2352x1568
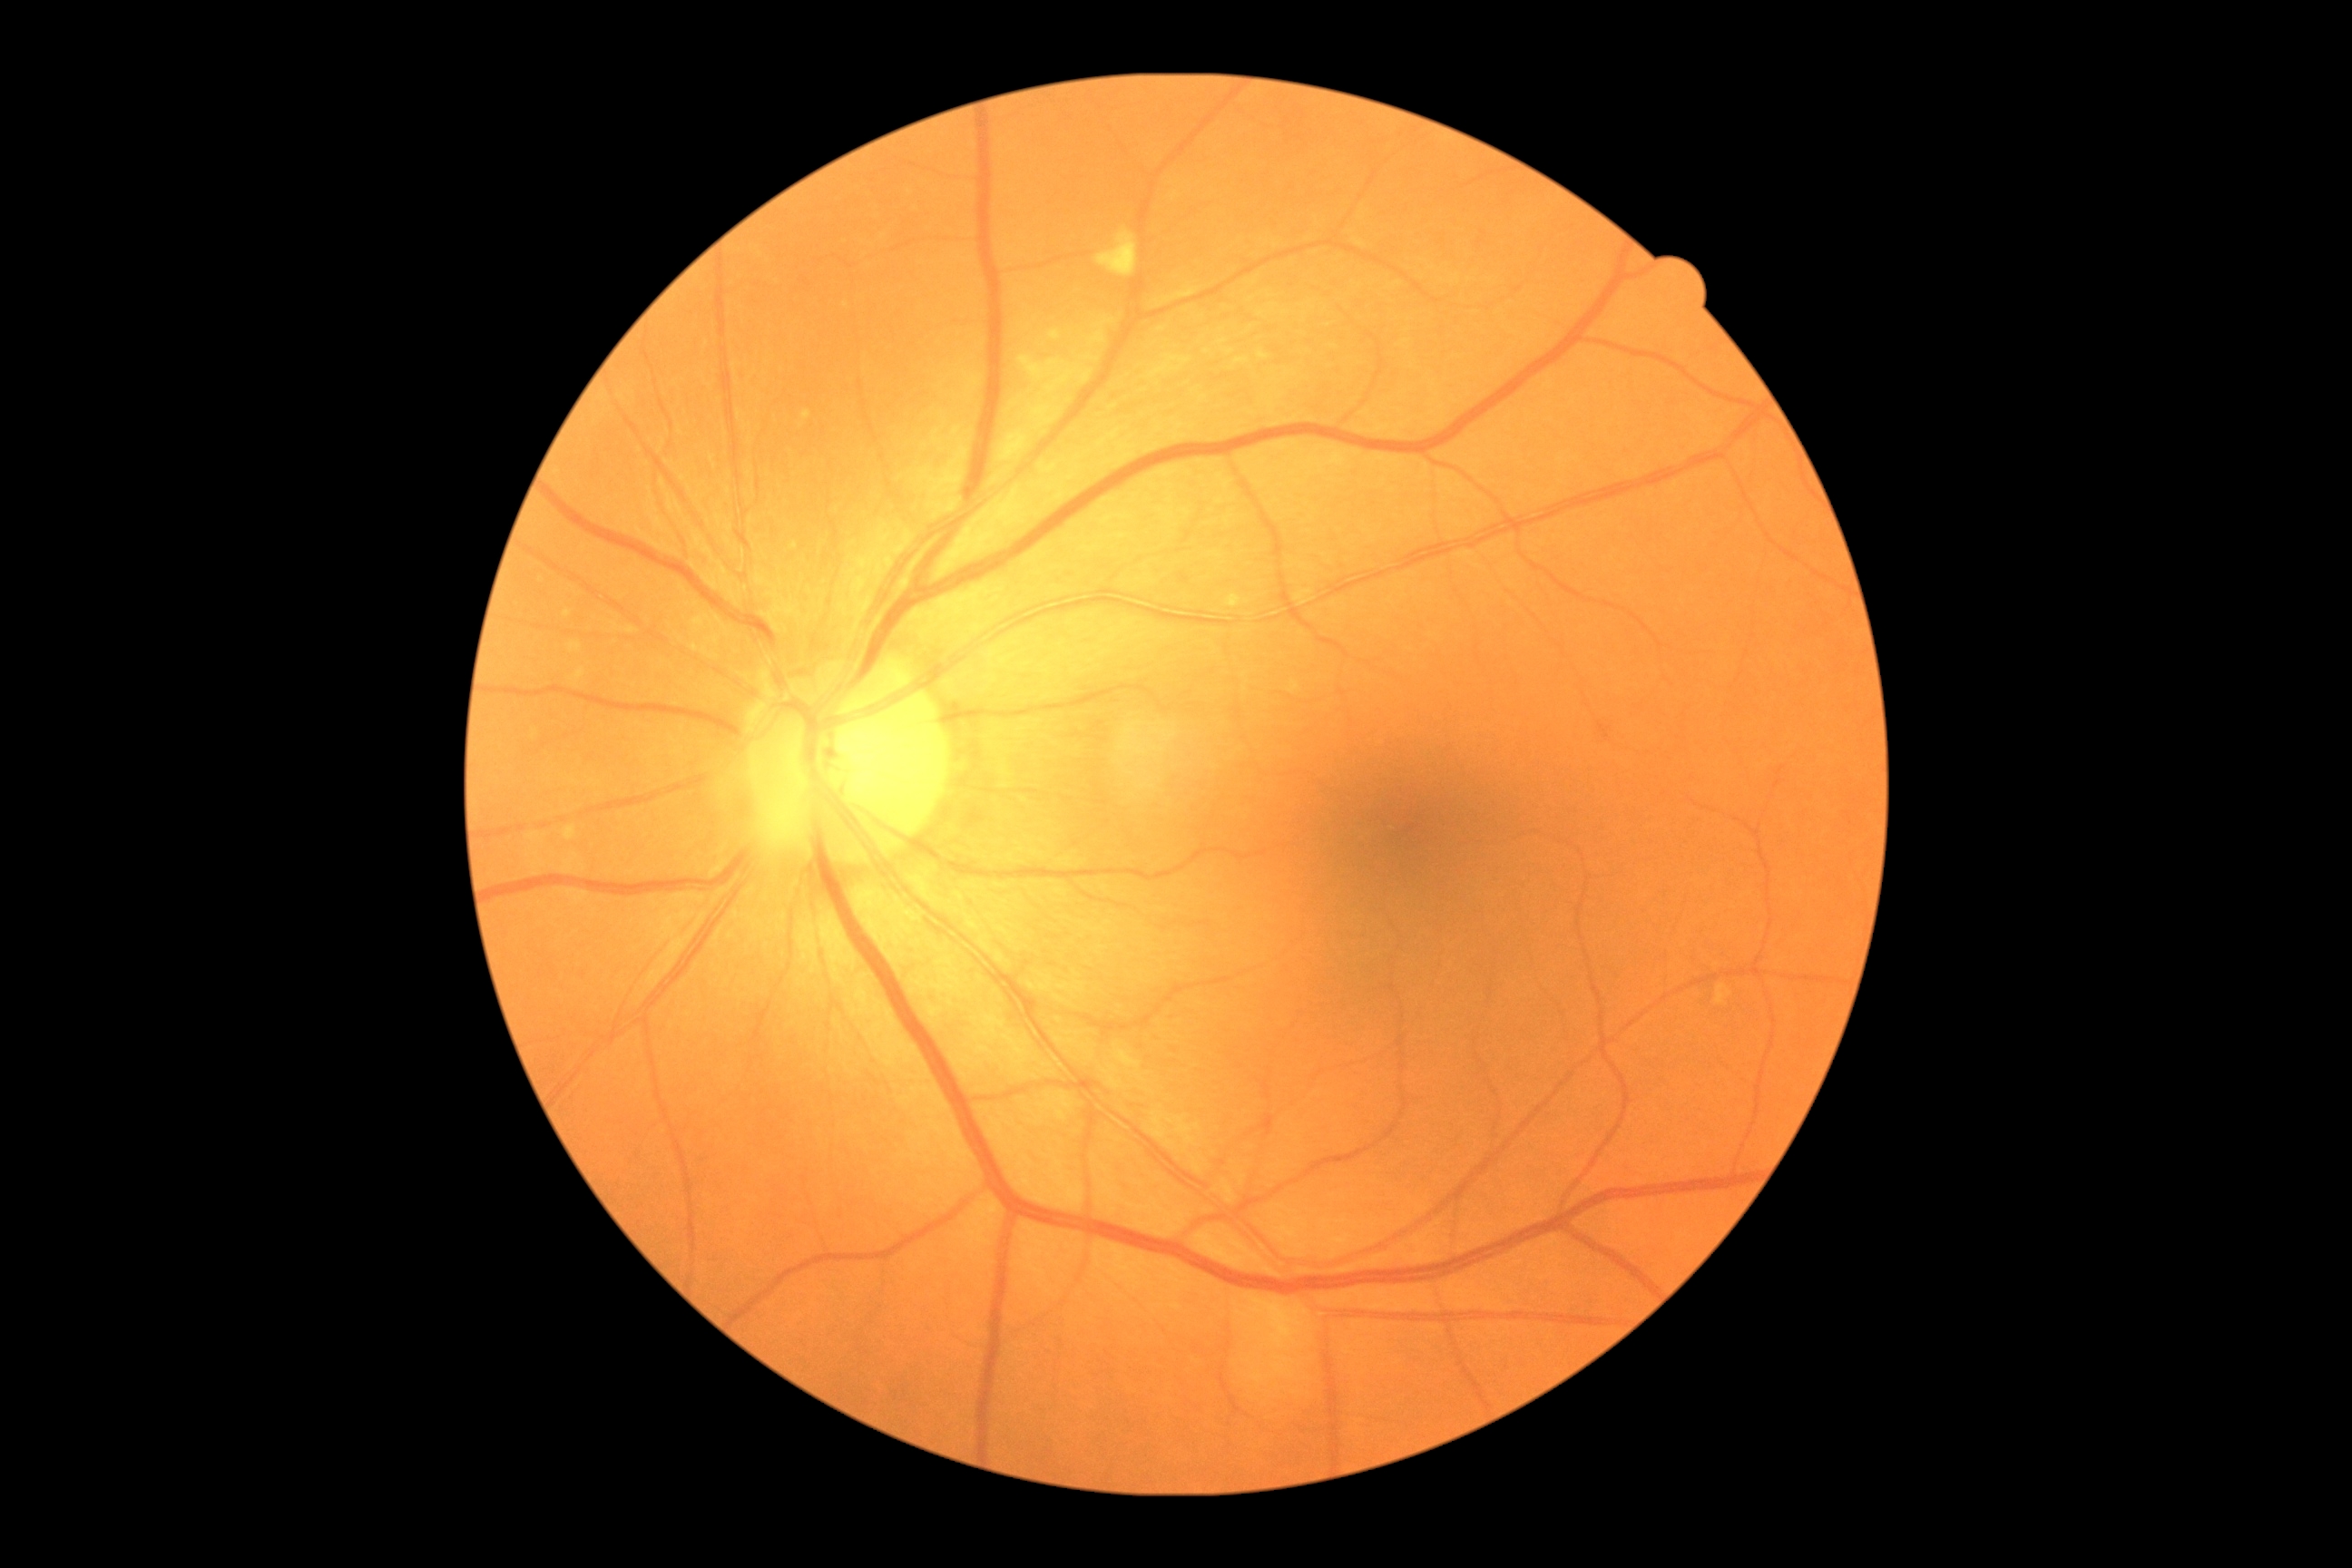 No signs of diabetic retinopathy.
Retinopathy: grade 0 (no apparent retinopathy).